1240 x 1240 pixels · wide-field fundus image from infant ROP screening.
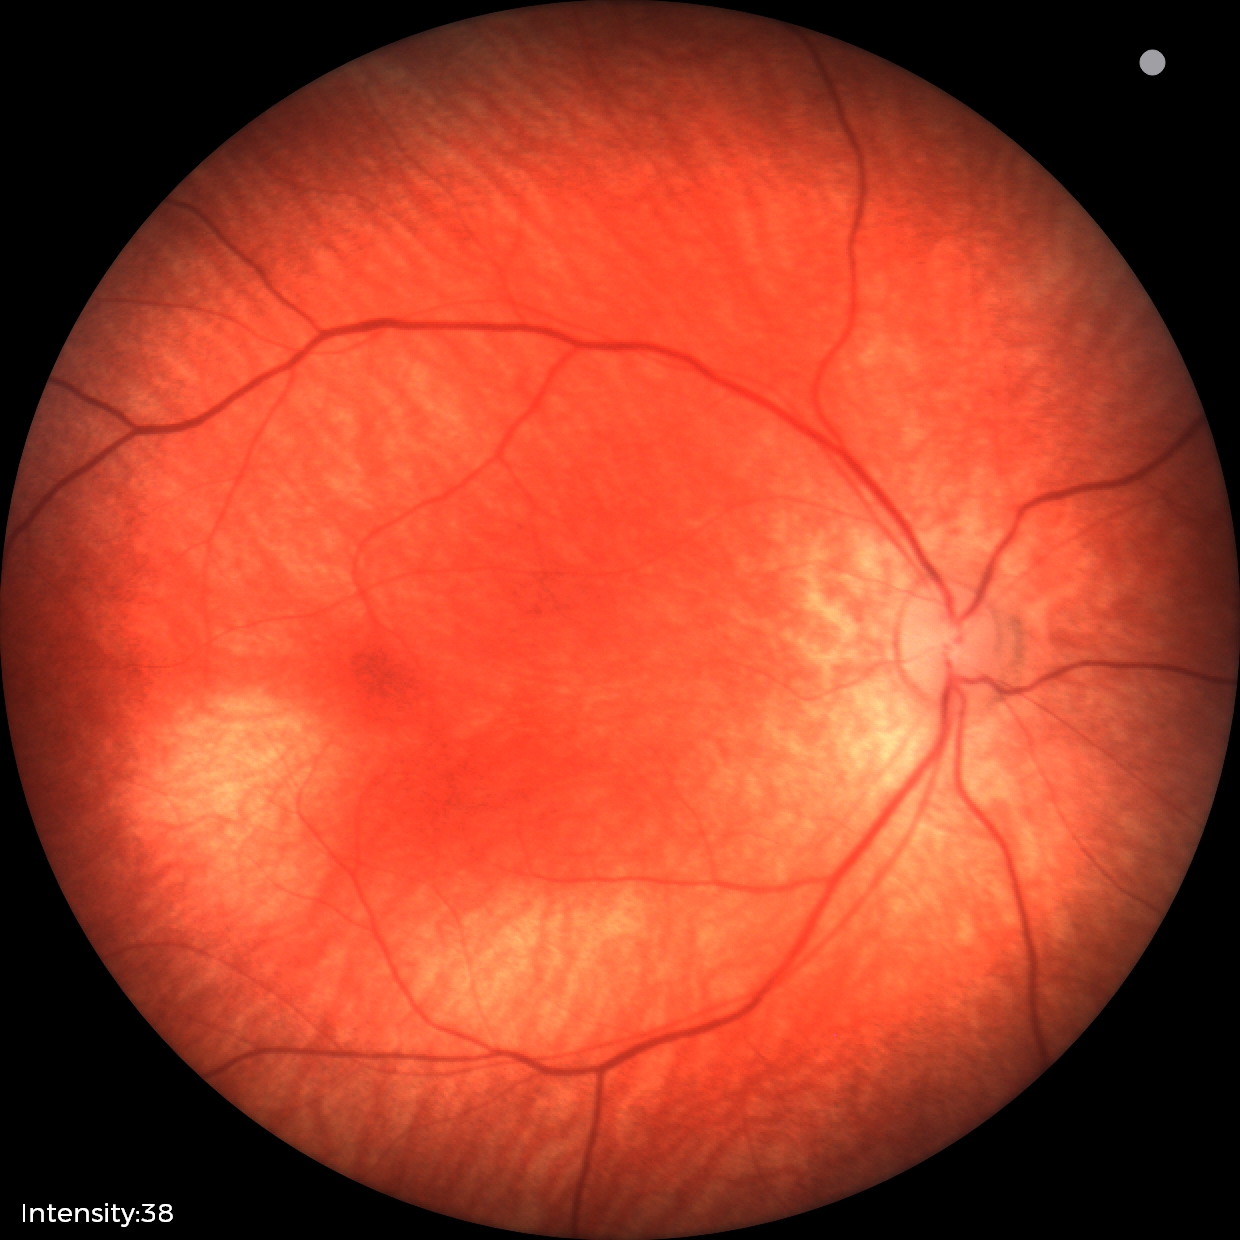
No retinal pathology identified on screening.